1932 x 1910 pixels.
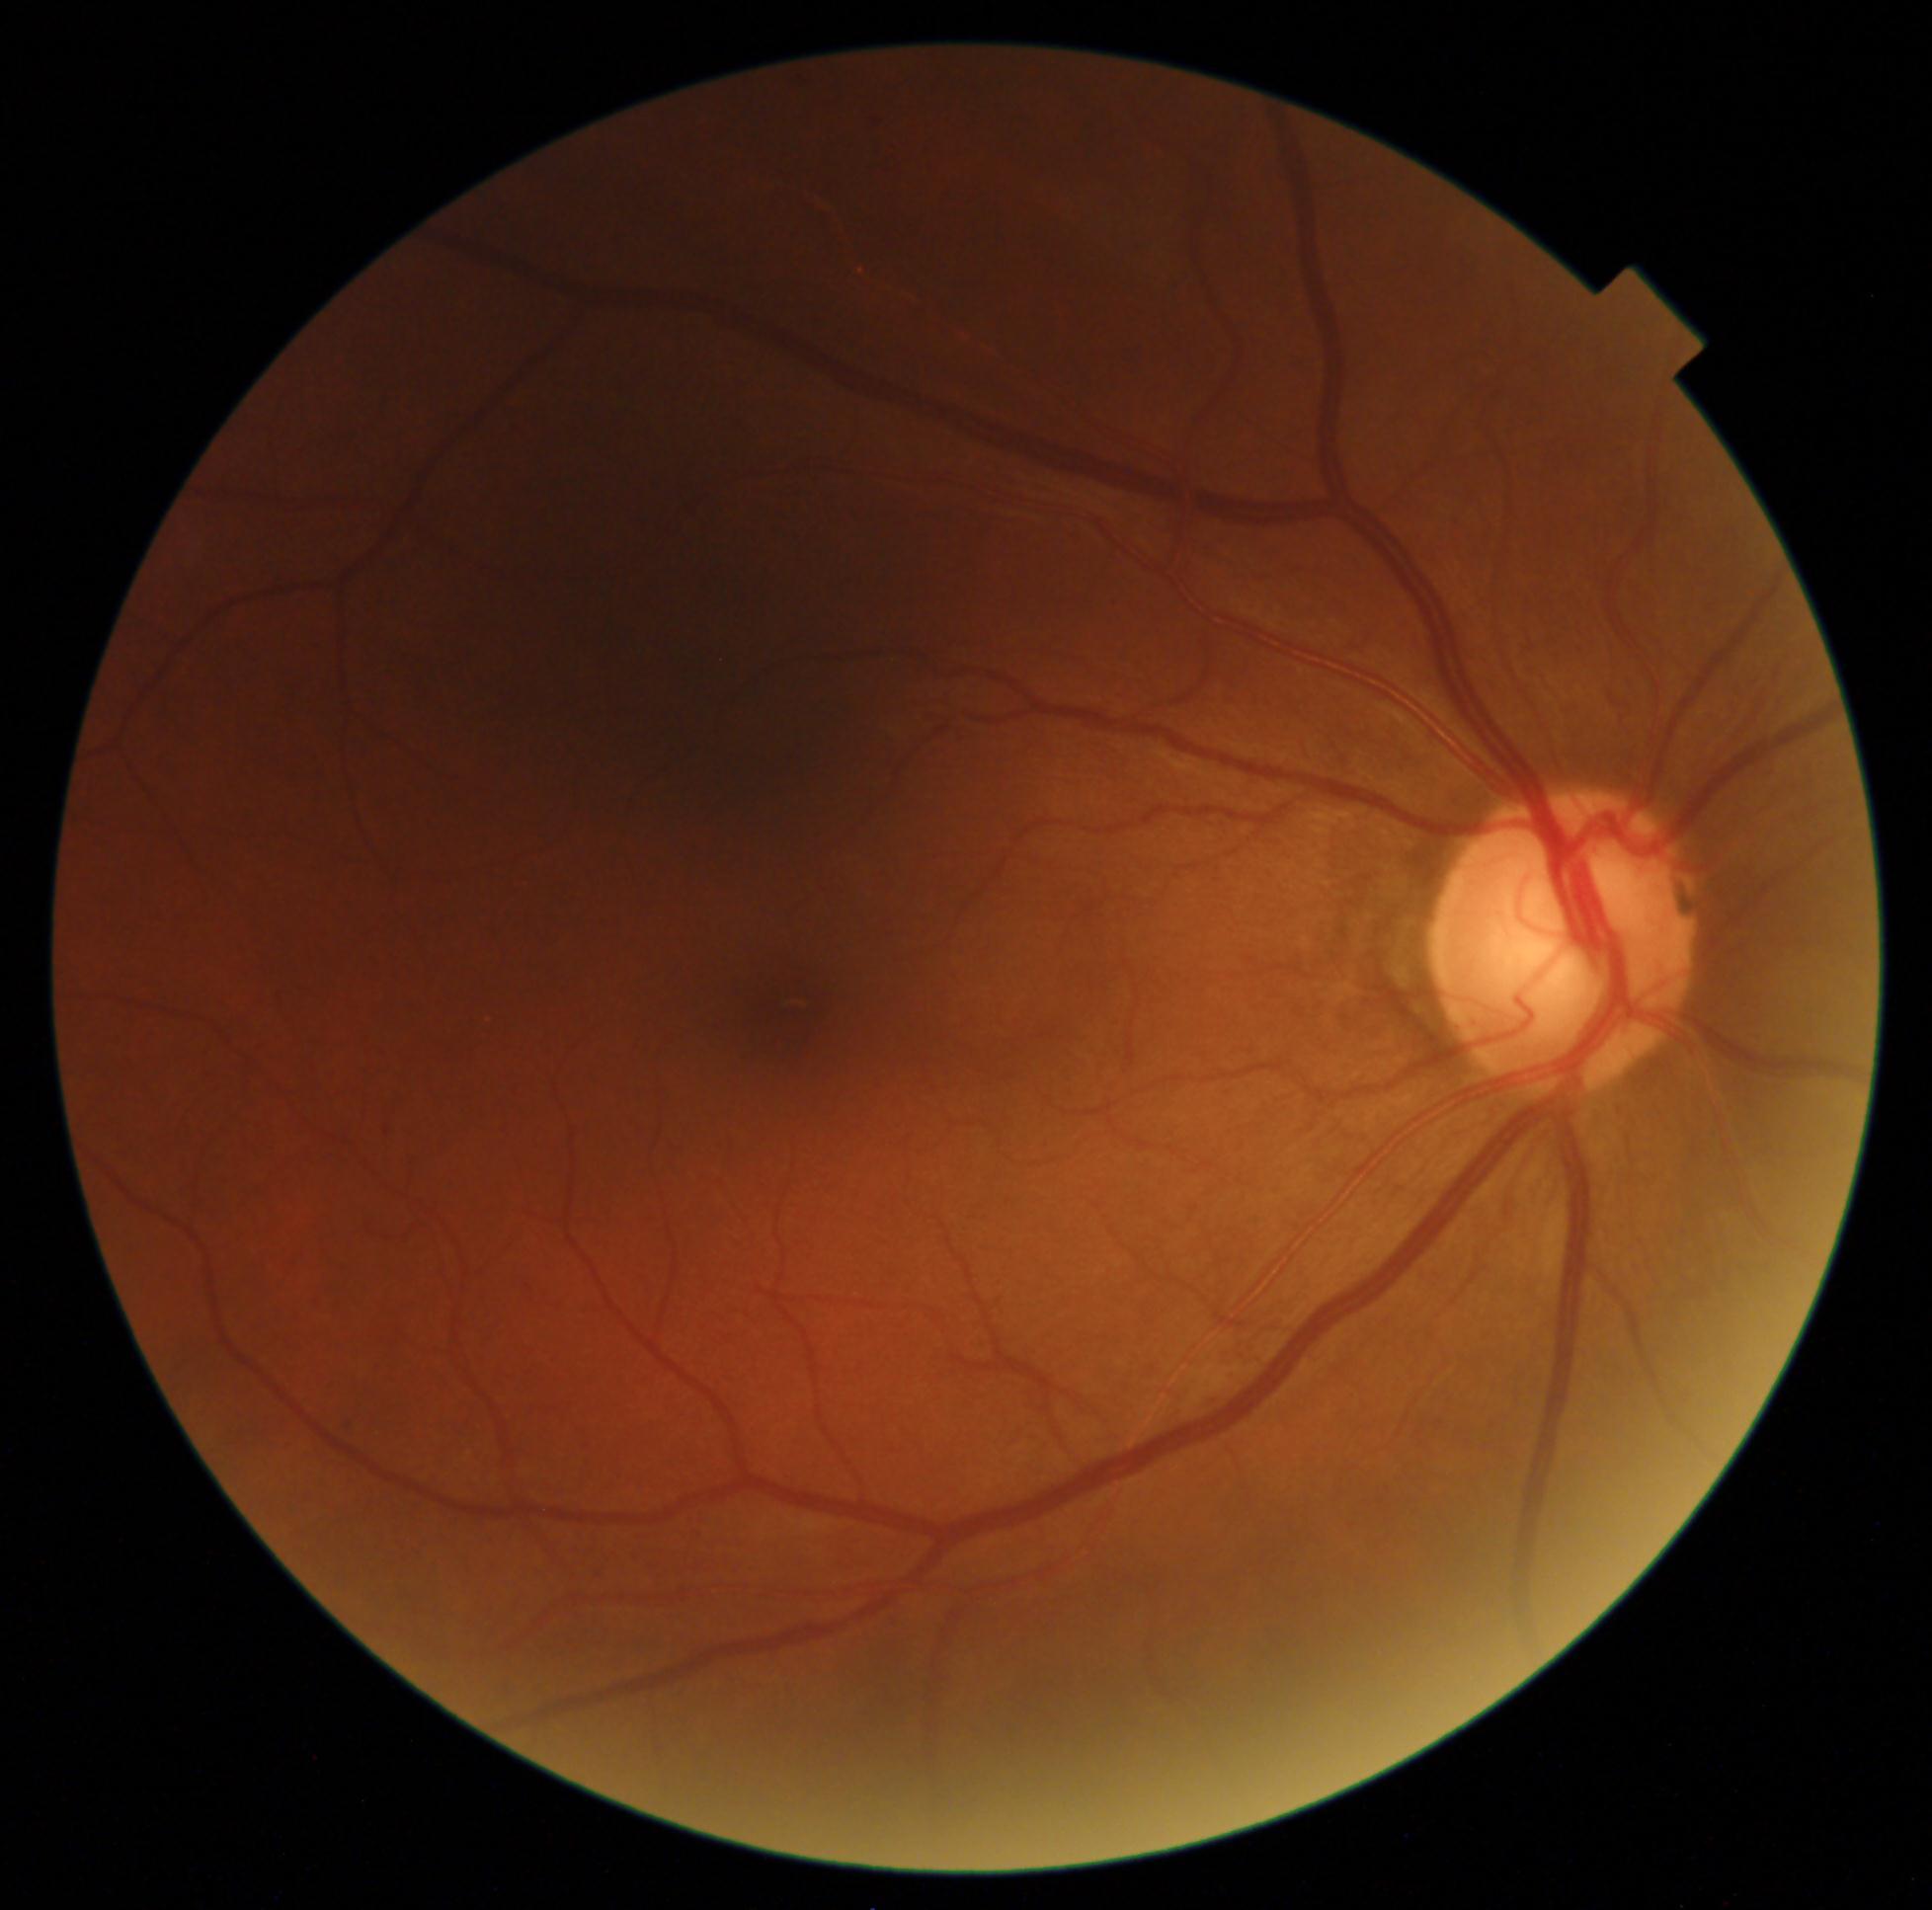

{"dr_grade": "grade 0 (no apparent retinopathy)", "dr_impression": "no signs of DR"}